FOV: 45 degrees · color fundus photograph · image size 848x848 · no pharmacologic dilation
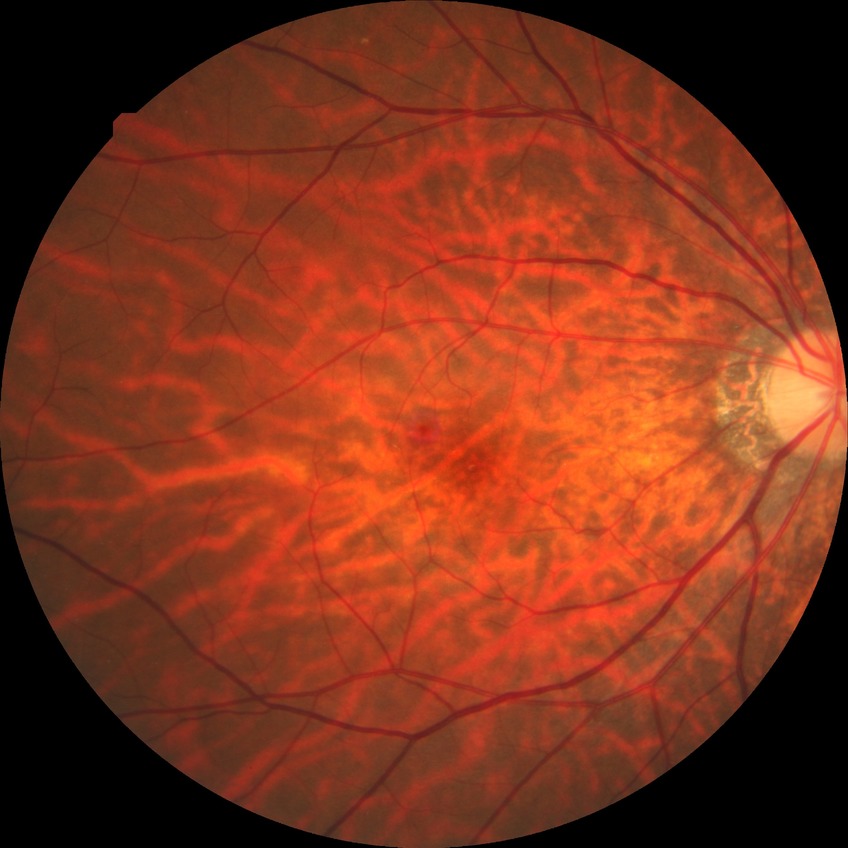
Diabetic retinopathy (DR): no diabetic retinopathy (NDR).